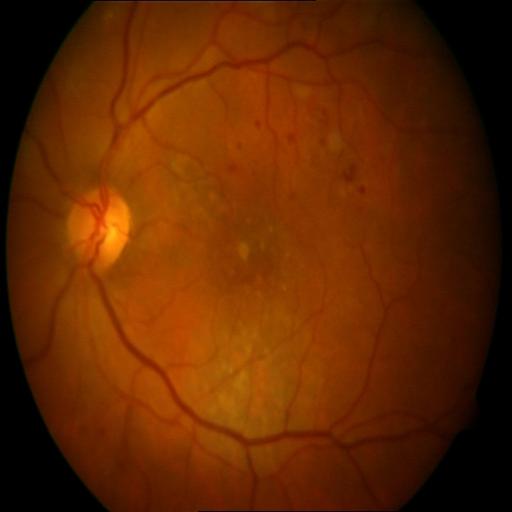

2 abnormalities. There is evidence of HR (hemorrhagic retinopathy) & MCA (microaneurysms).